Davis DR grading; no pharmacologic dilation: 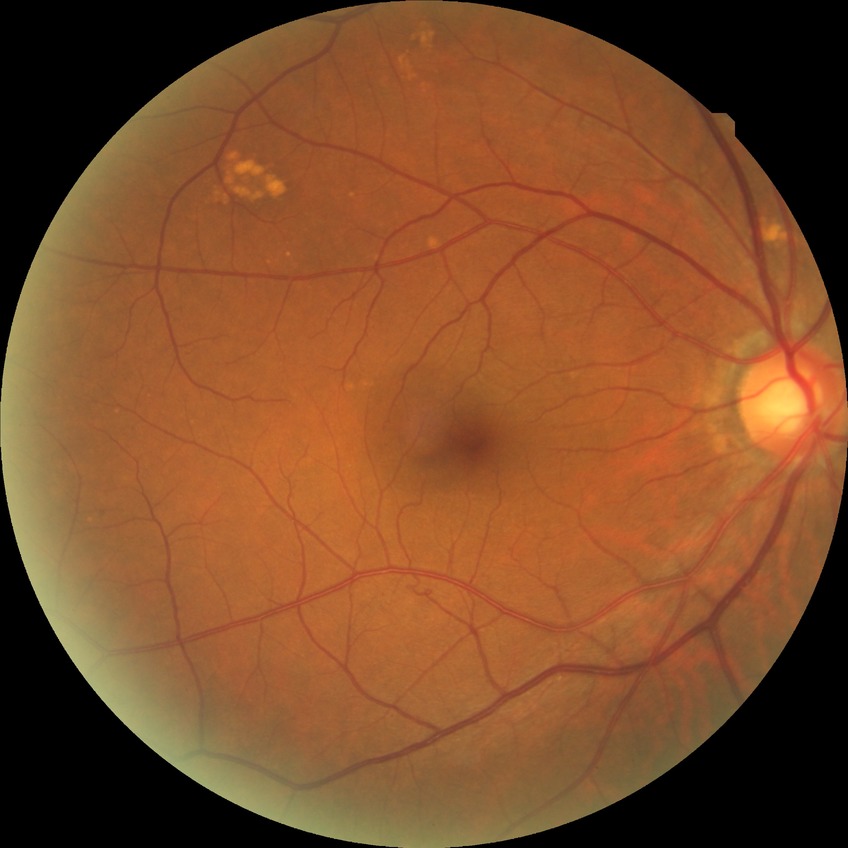
Diabetic retinopathy (DR): NDR (no diabetic retinopathy).